Fundus photo · FOV: 45 degrees: 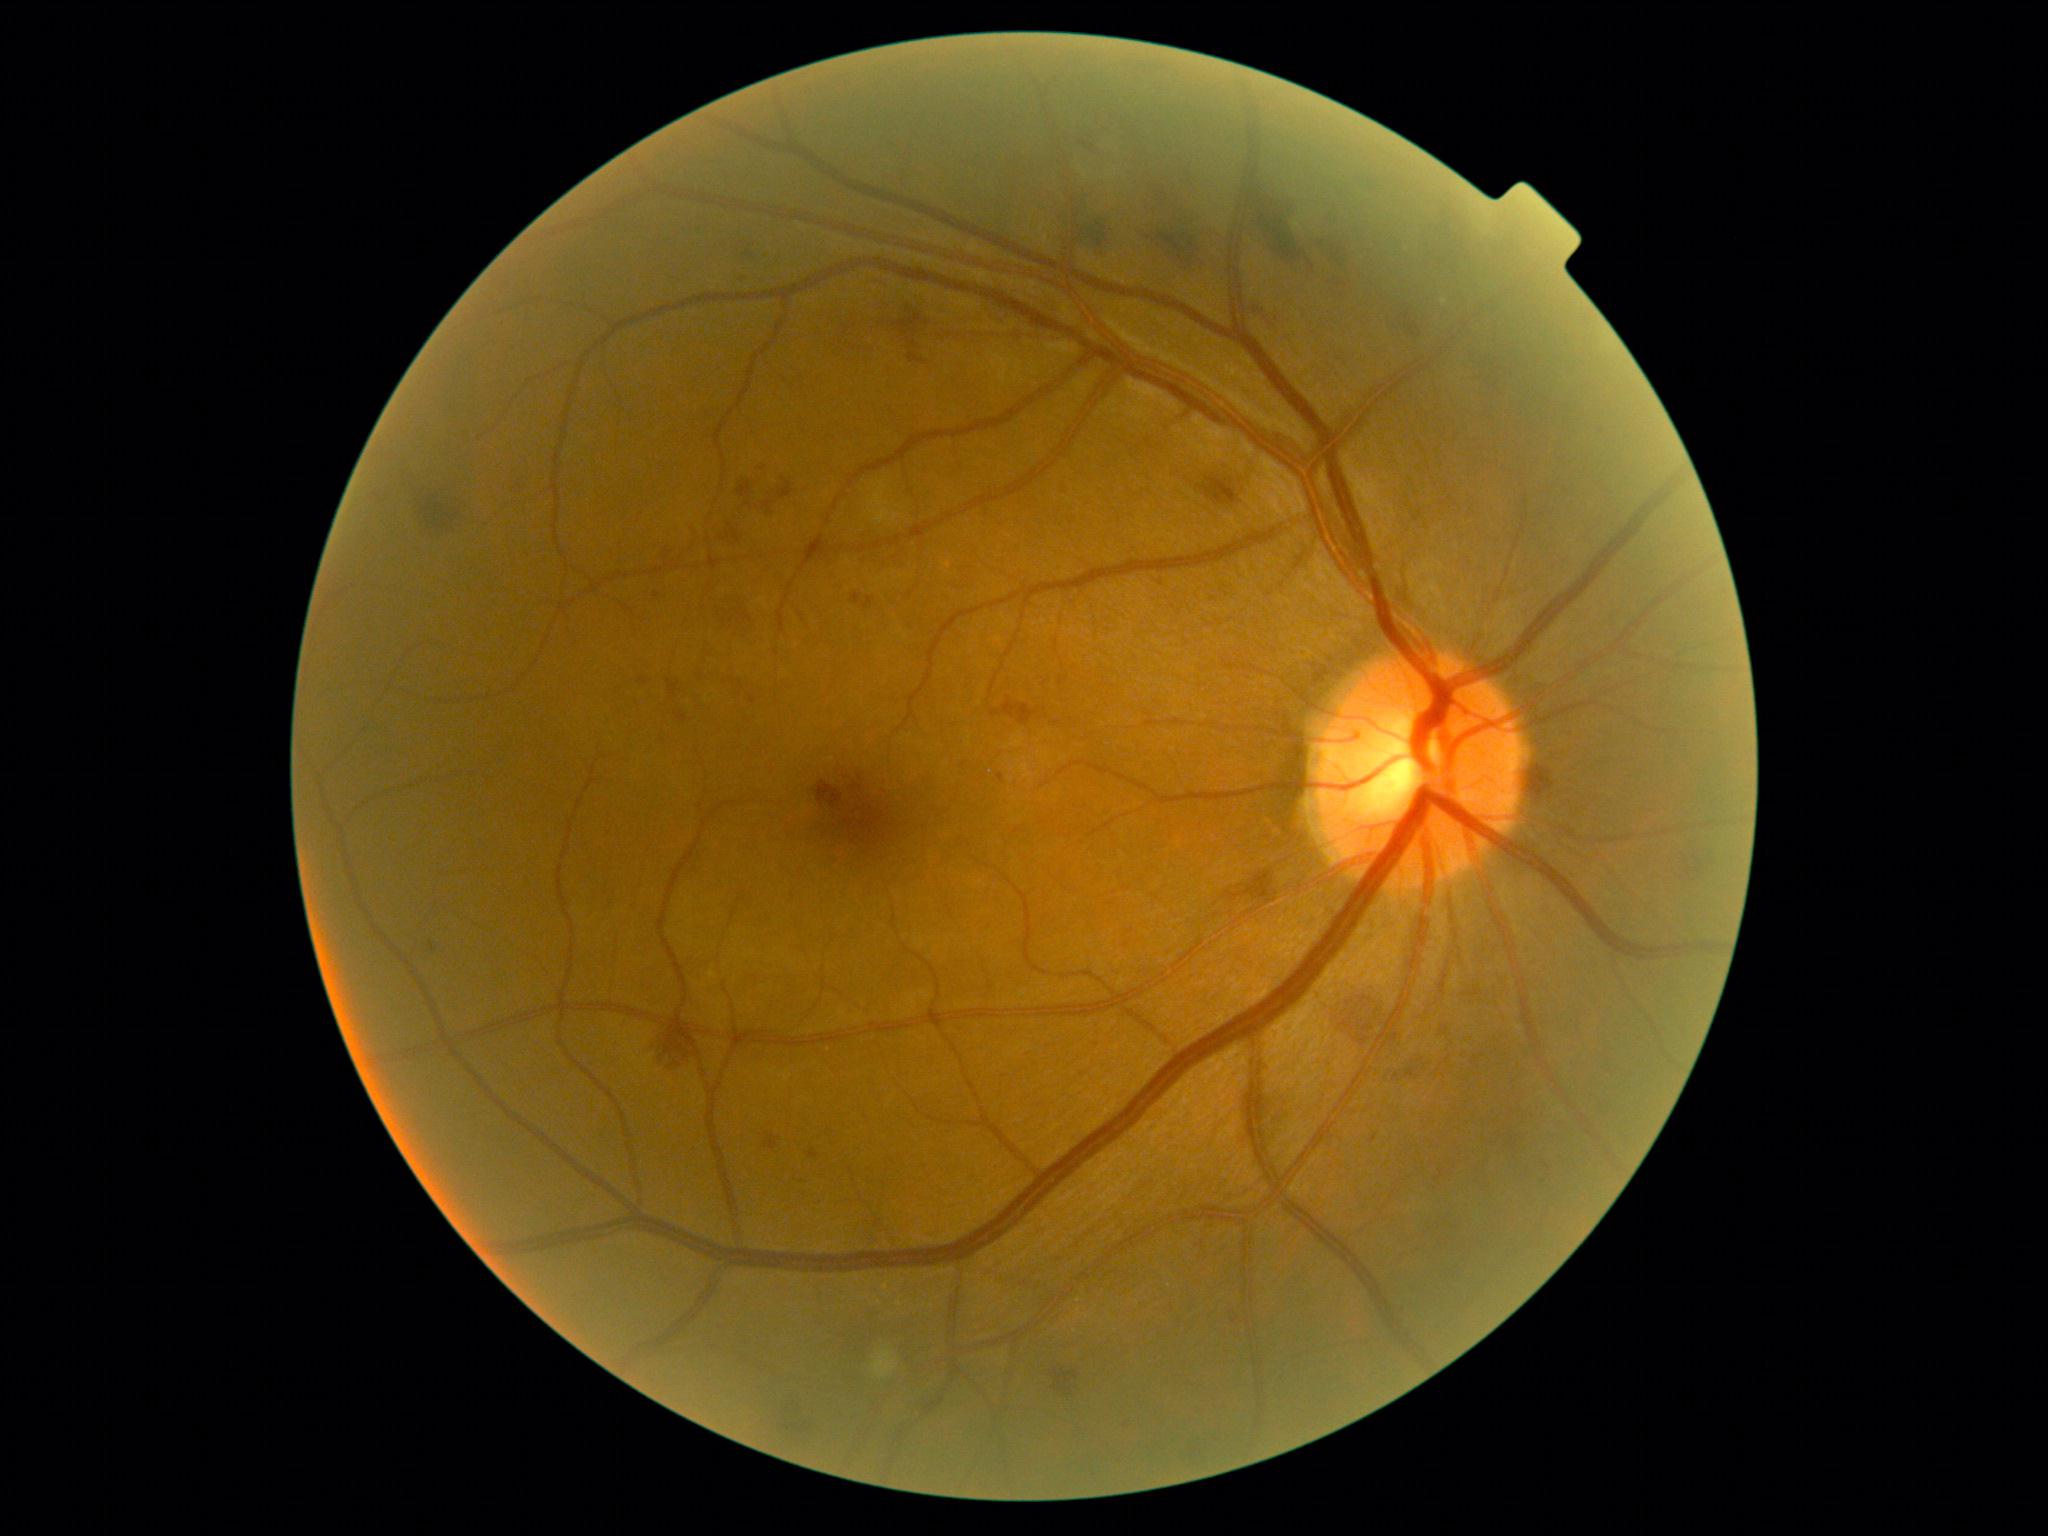

The retinopathy is classified as non-proliferative diabetic retinopathy.
DR stage is moderate non-proliferative diabetic retinopathy (grade 2).